Captured on a Remidio FOP fundus camera. Retinal fundus photograph. 1659 x 2212 pixels — 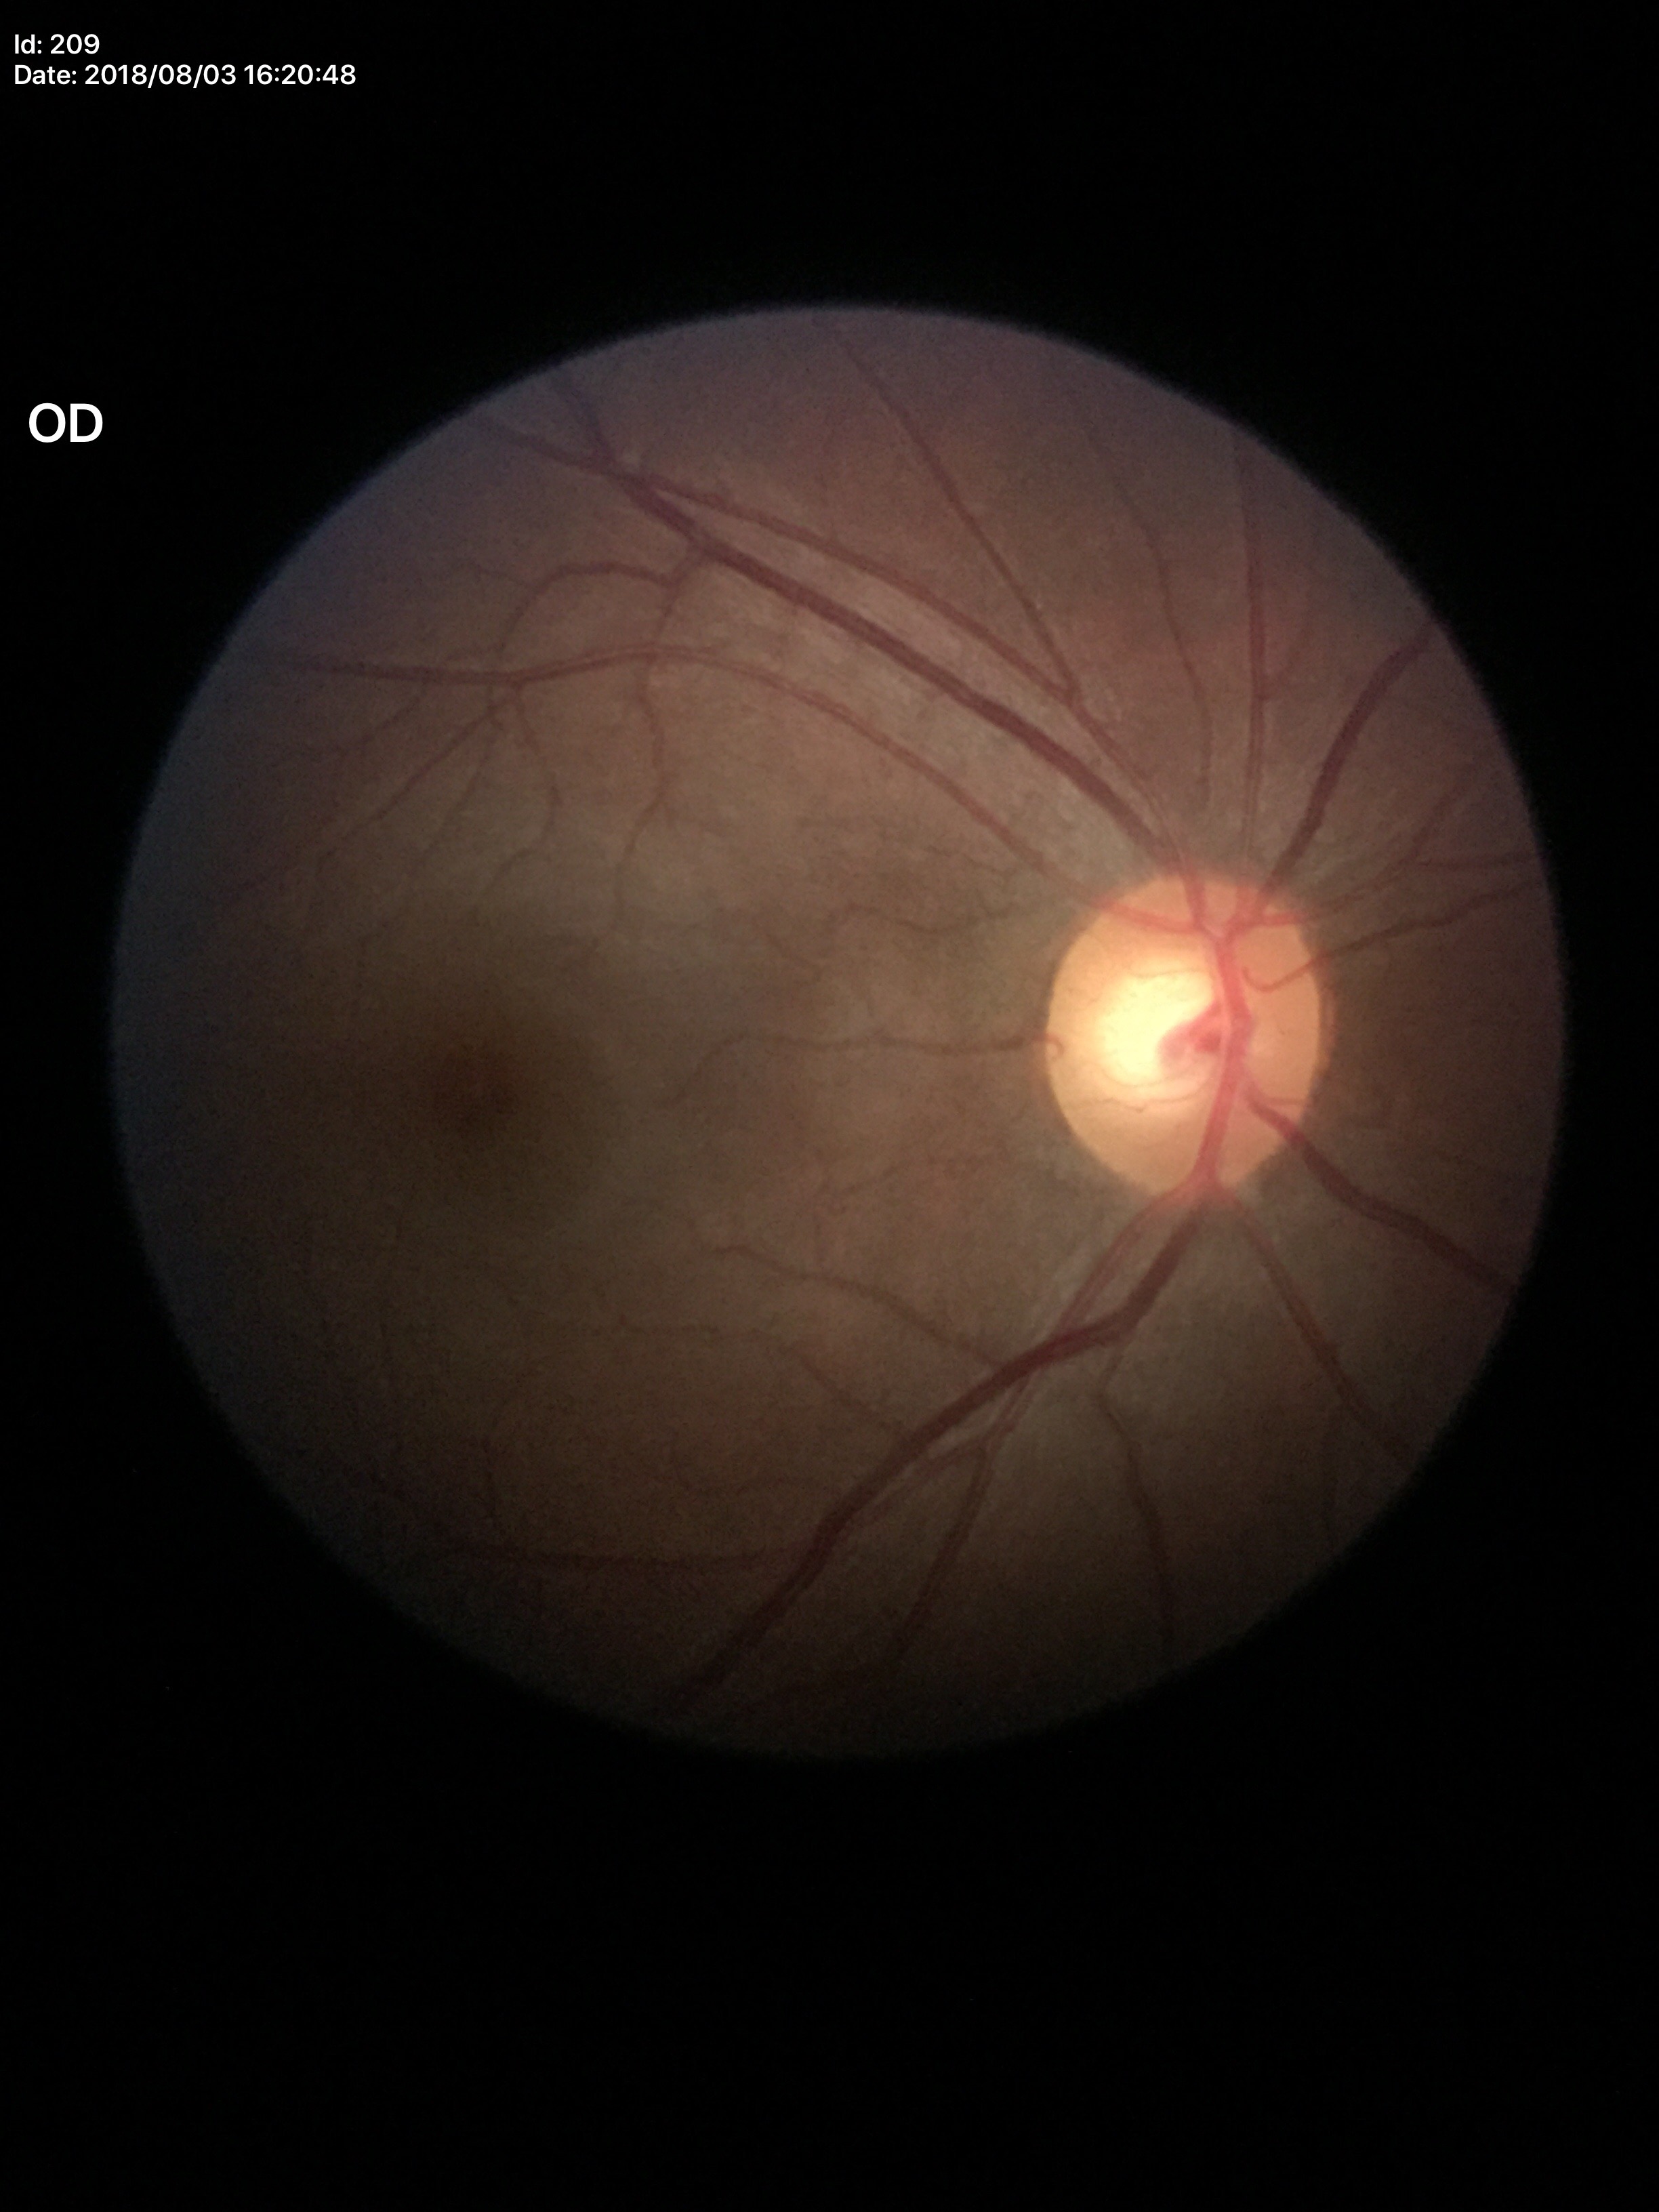 Vertical CDR (VCDR) is 0.52. No glaucomatous findings.